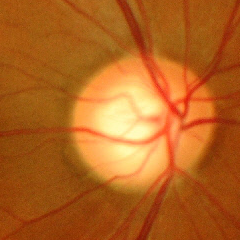 There is evidence of severe glaucomatous damage.